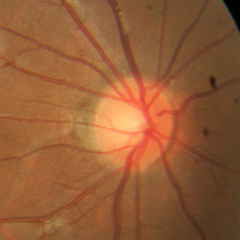 Q: What stage of glaucoma is present?
A: No glaucomatous findings.